Acquired on the Clarity RetCam 3. Wide-field fundus photograph from neonatal ROP screening: 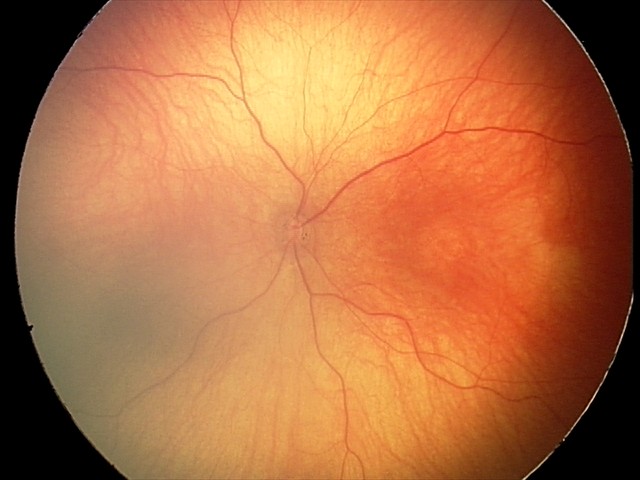
Normal screening examination.